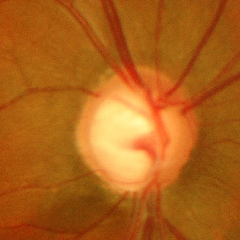

Q: What stage of glaucoma is present?
A: Yes — advanced glaucomatous optic neuropathy.